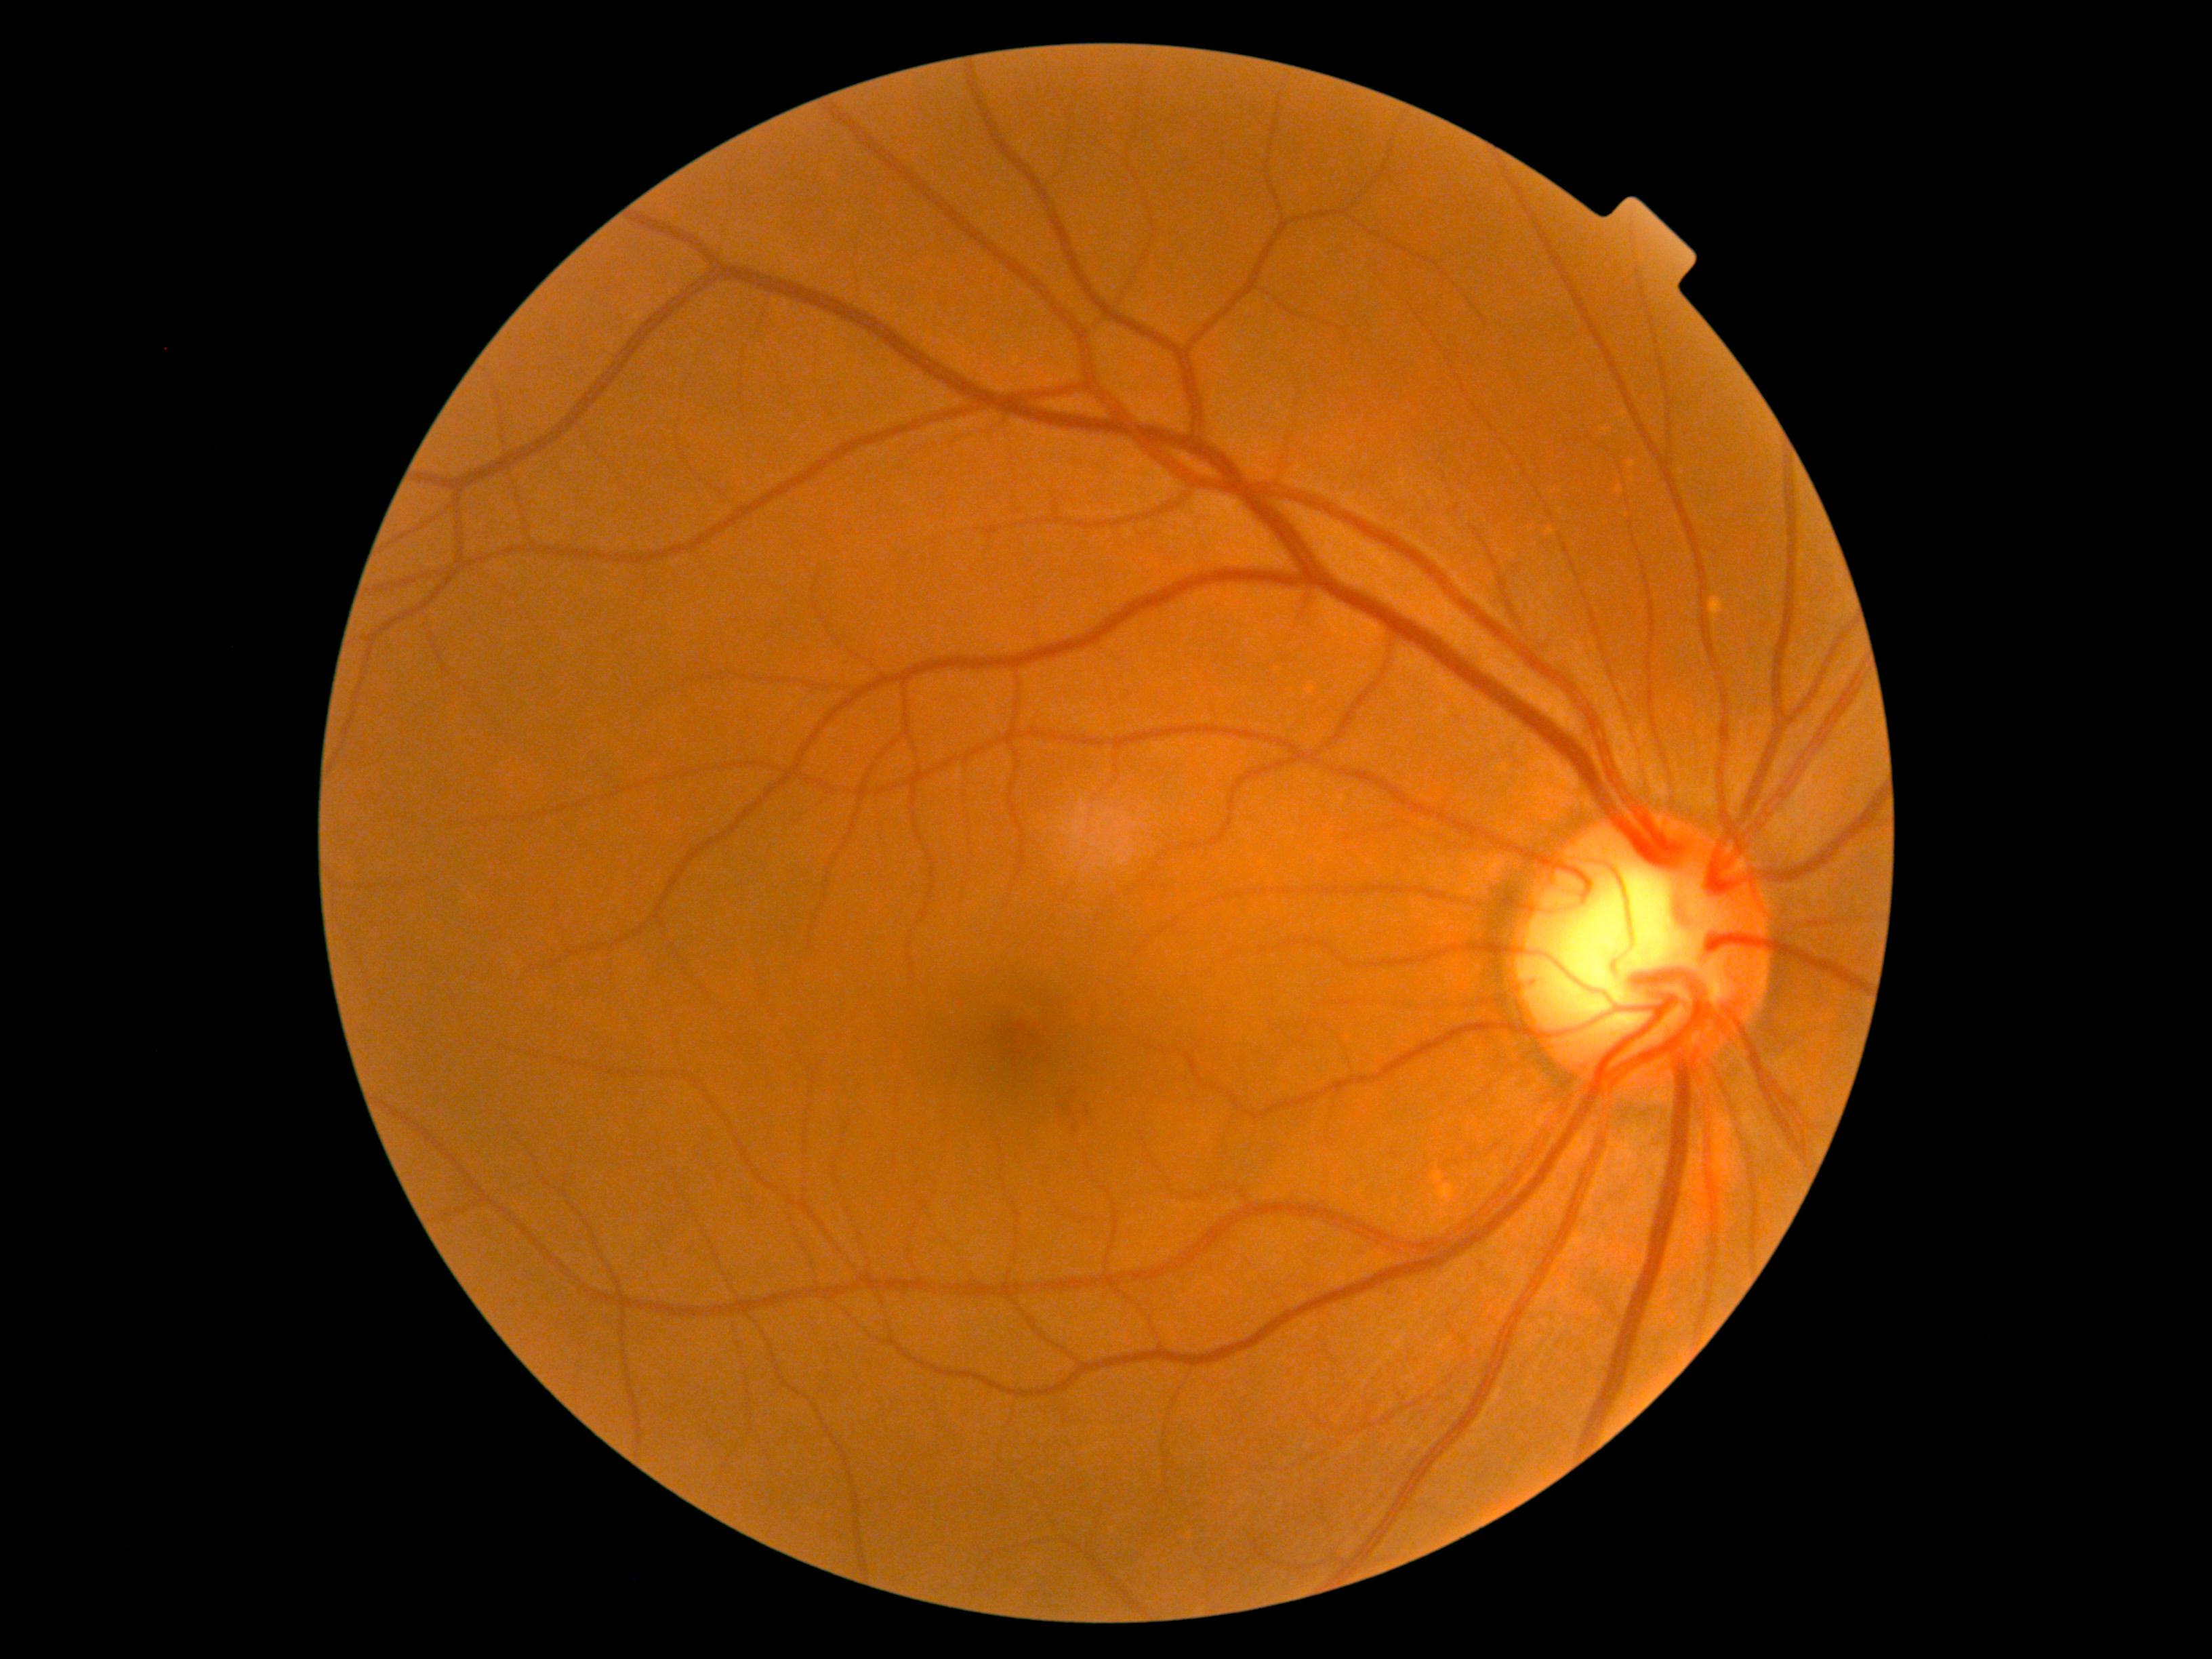 The retinopathy is classified as non-proliferative diabetic retinopathy. Diabetic retinopathy (DR) is grade 2 (moderate NPDR).